Ultra-widefield fundus mosaic
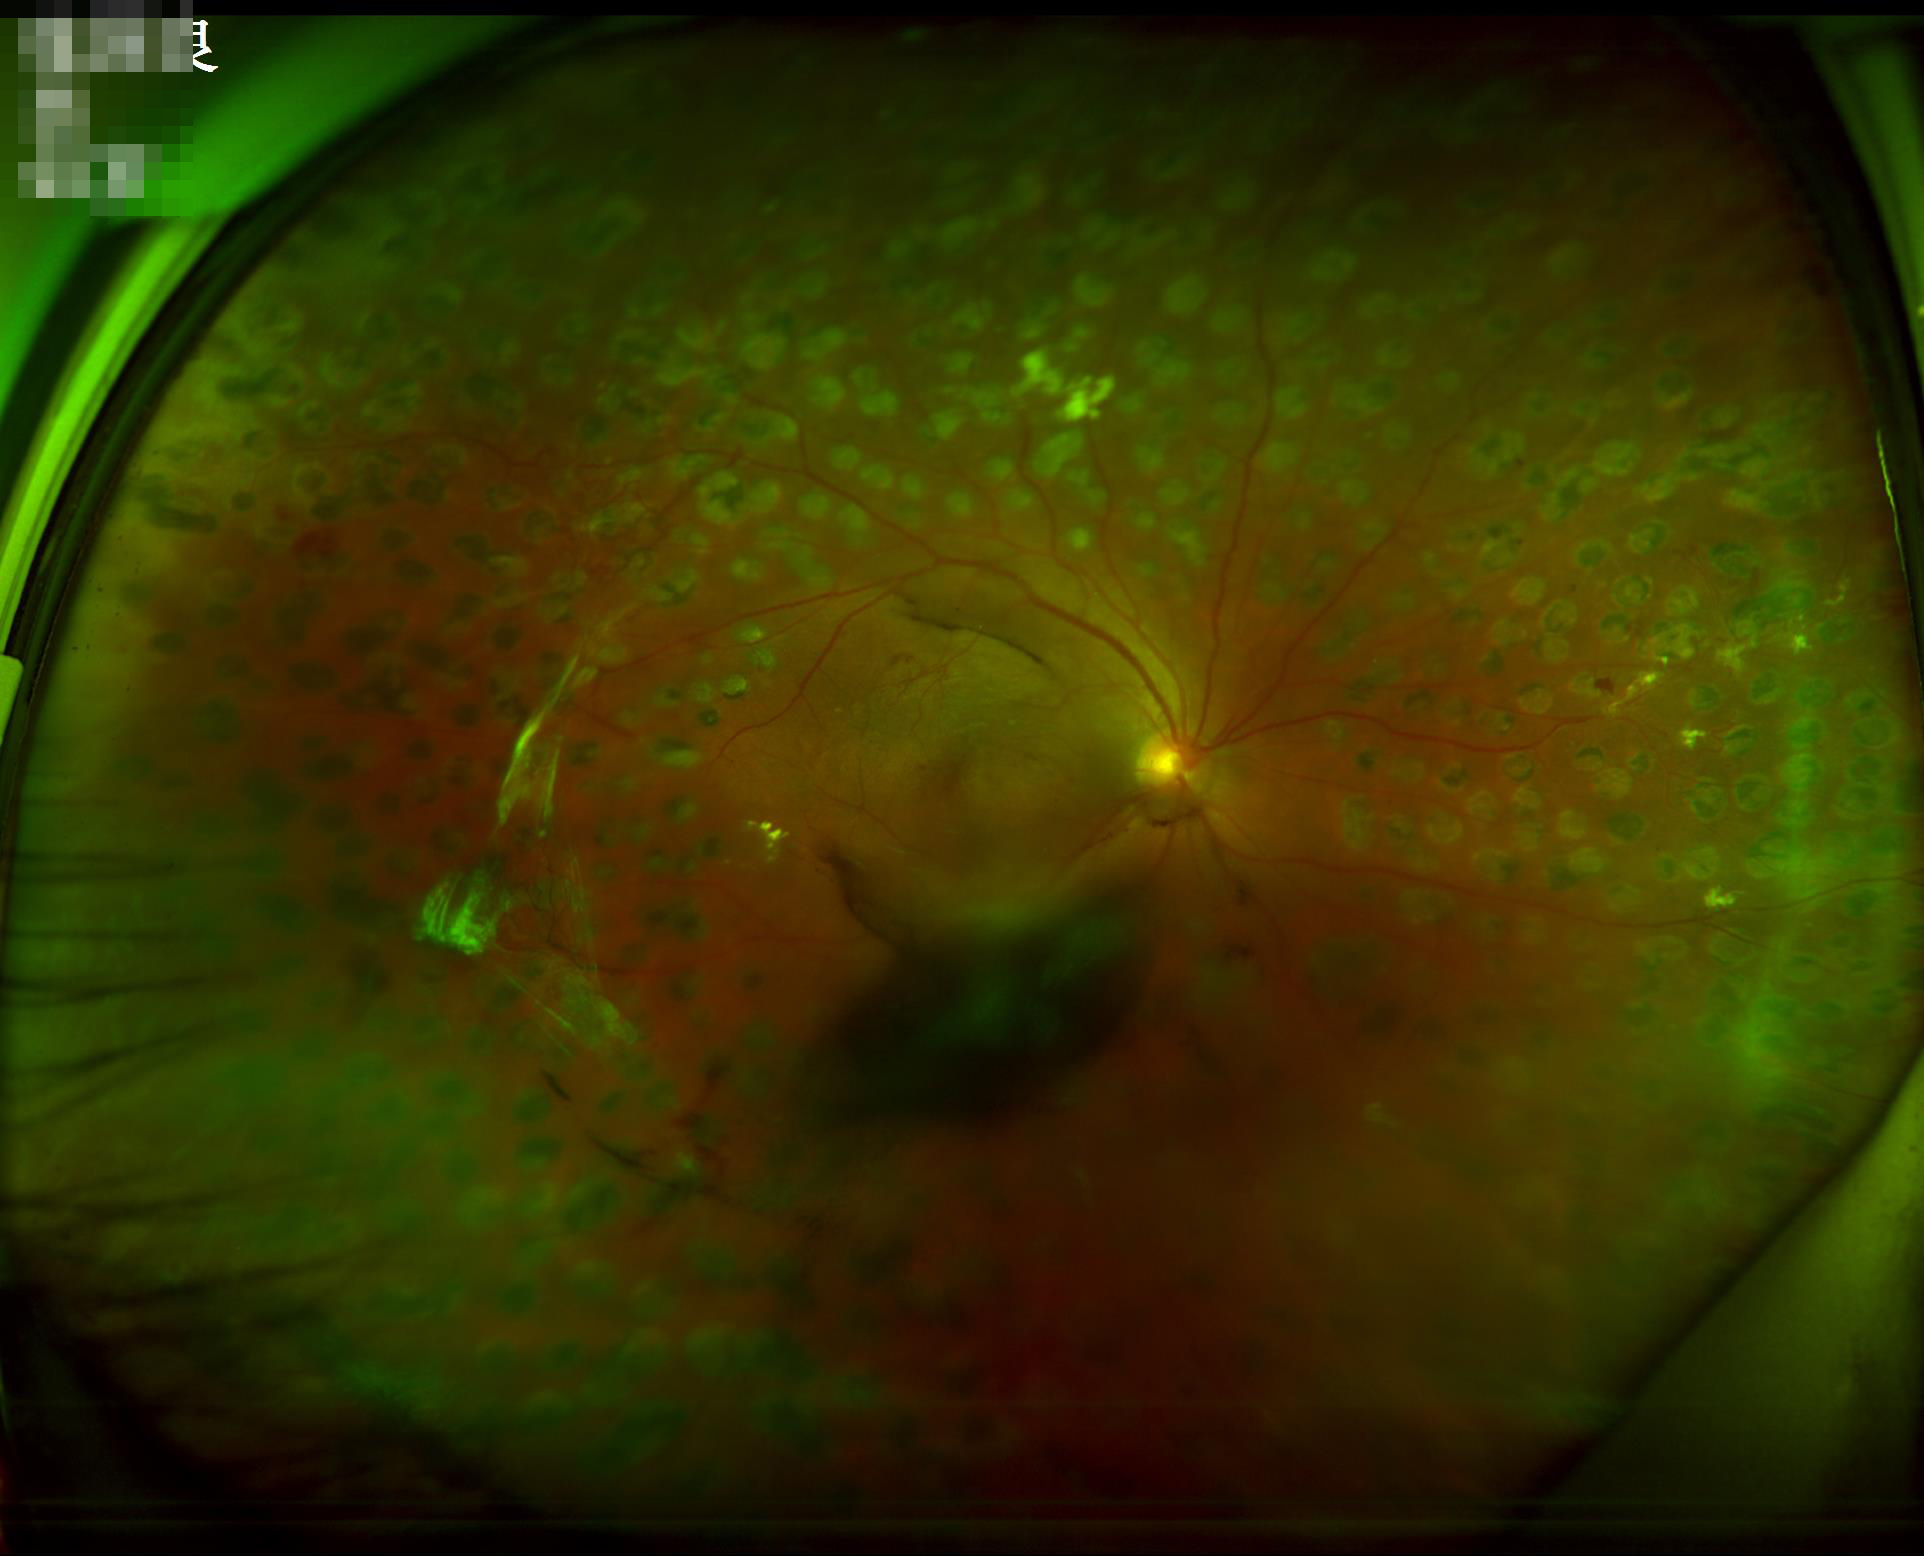
Even illumination with no color cast.
Acceptable image quality.
Noticeable blur in the optic disc, vessels, or background.